Infant wide-field fundus photograph; image size 640x480; captured with the Clarity RetCam 3 (130° field of view).
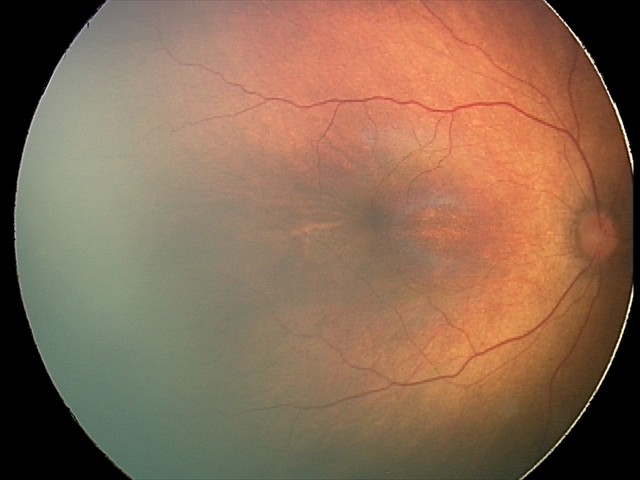

No plus disease. Screening series with status post retinopathy of prematurity.